45-degree field of view; graded on the modified Davis scale
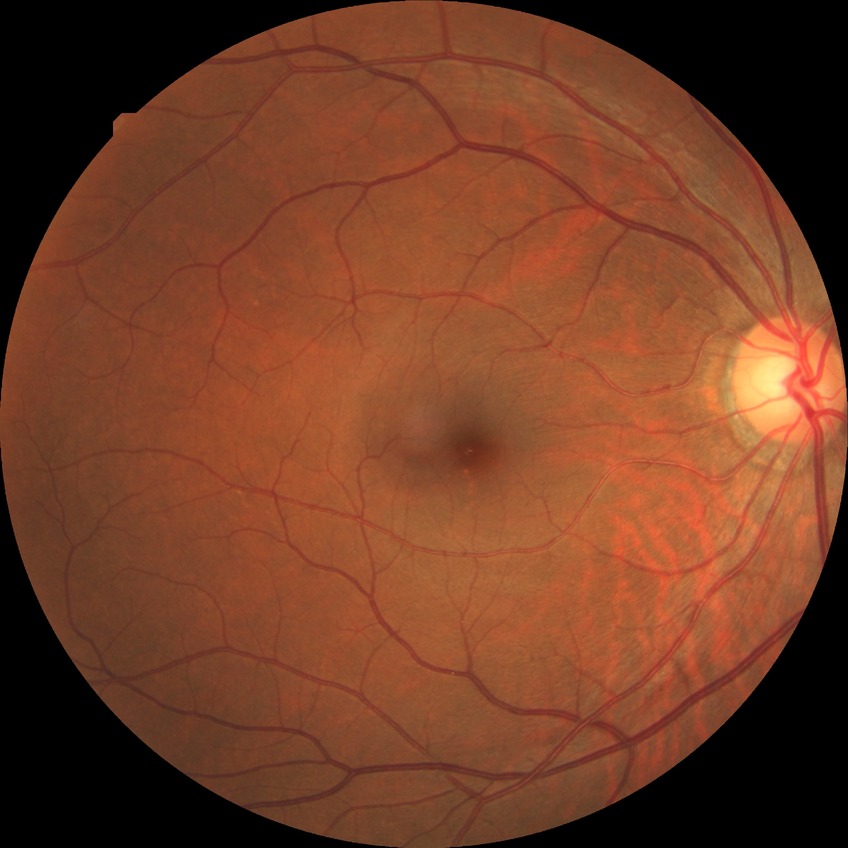 Diabetic retinopathy (DR): NDR (no diabetic retinopathy).